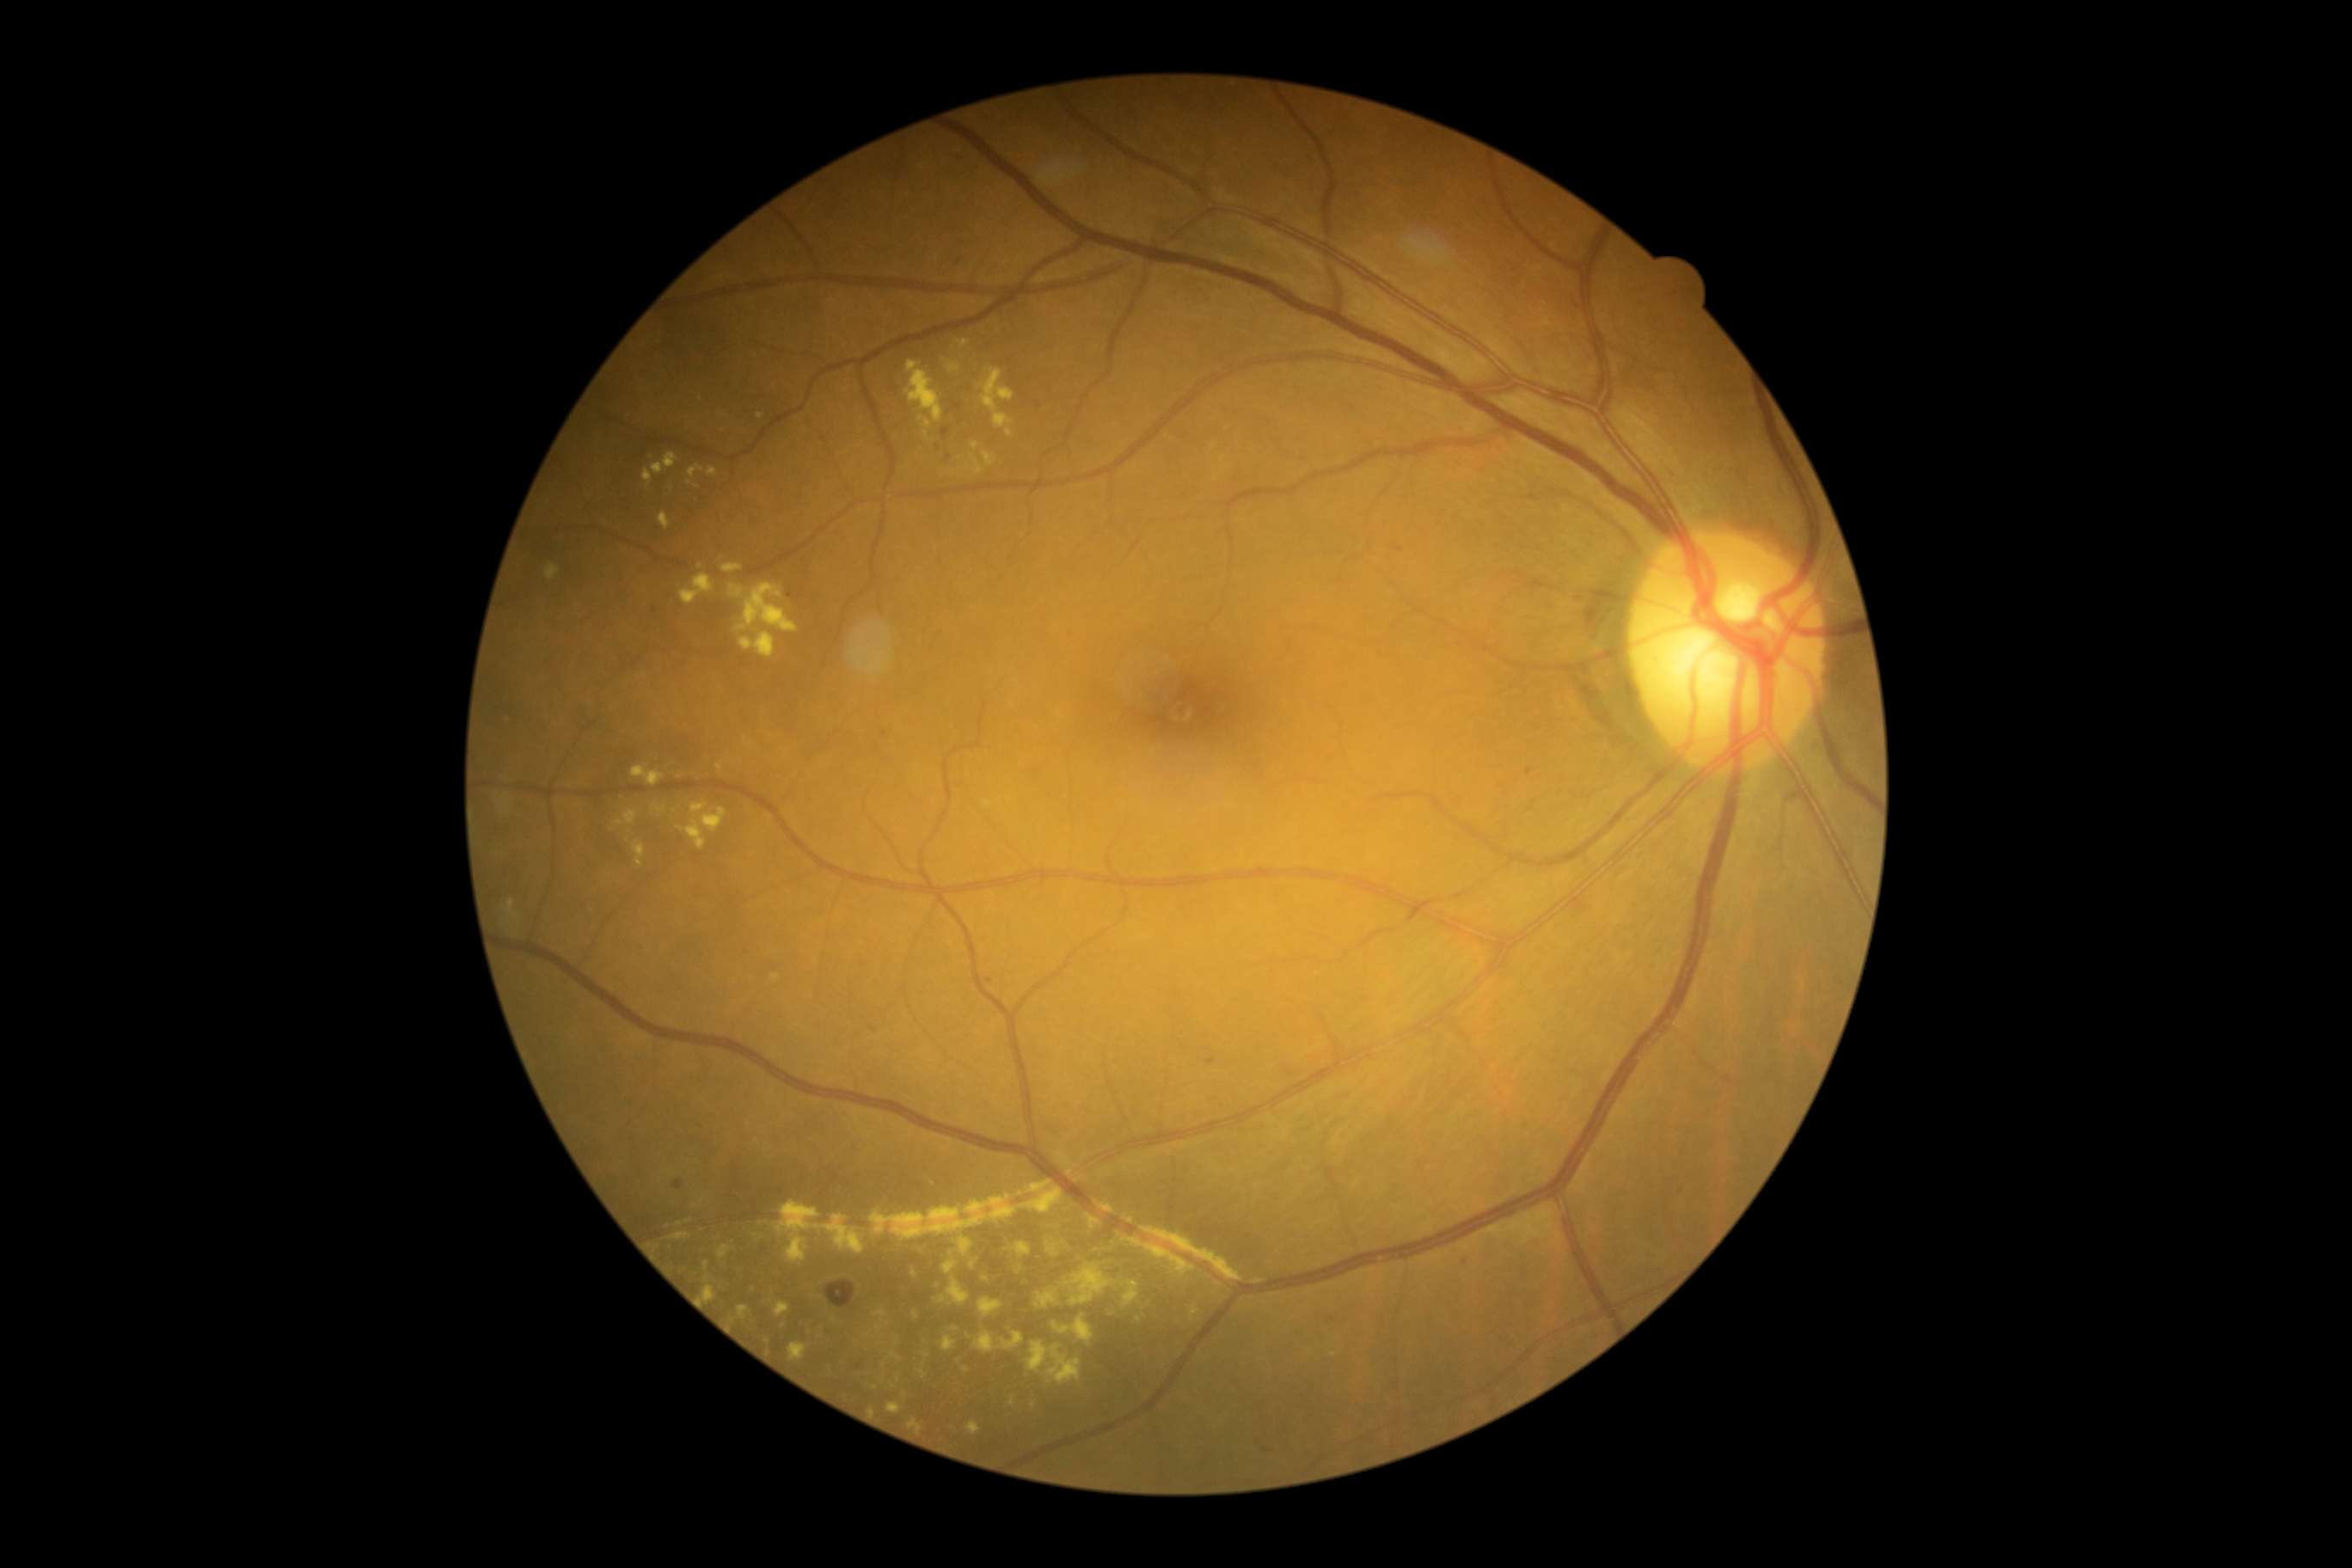
Diabetic retinopathy (DR) is moderate NPDR (grade 2)
Representative lesions:
hard exudates (EXs) (more not shown): [1117,1232,1197,1277]; [984,800,993,807]; [678,807,726,850]; [1086,1215,1101,1230]; [890,1352,902,1363]; [689,465,704,479]; [1008,1397,1015,1407]; [720,1246,732,1259]; [924,431,931,443]; [1046,1239,1067,1258]; [971,455,984,475]; [946,1278,969,1306]
Additional small EXs near 1069:1172; 706:1279; 884:1366; 1216:479; 675:812; 706:1264; 898:1340